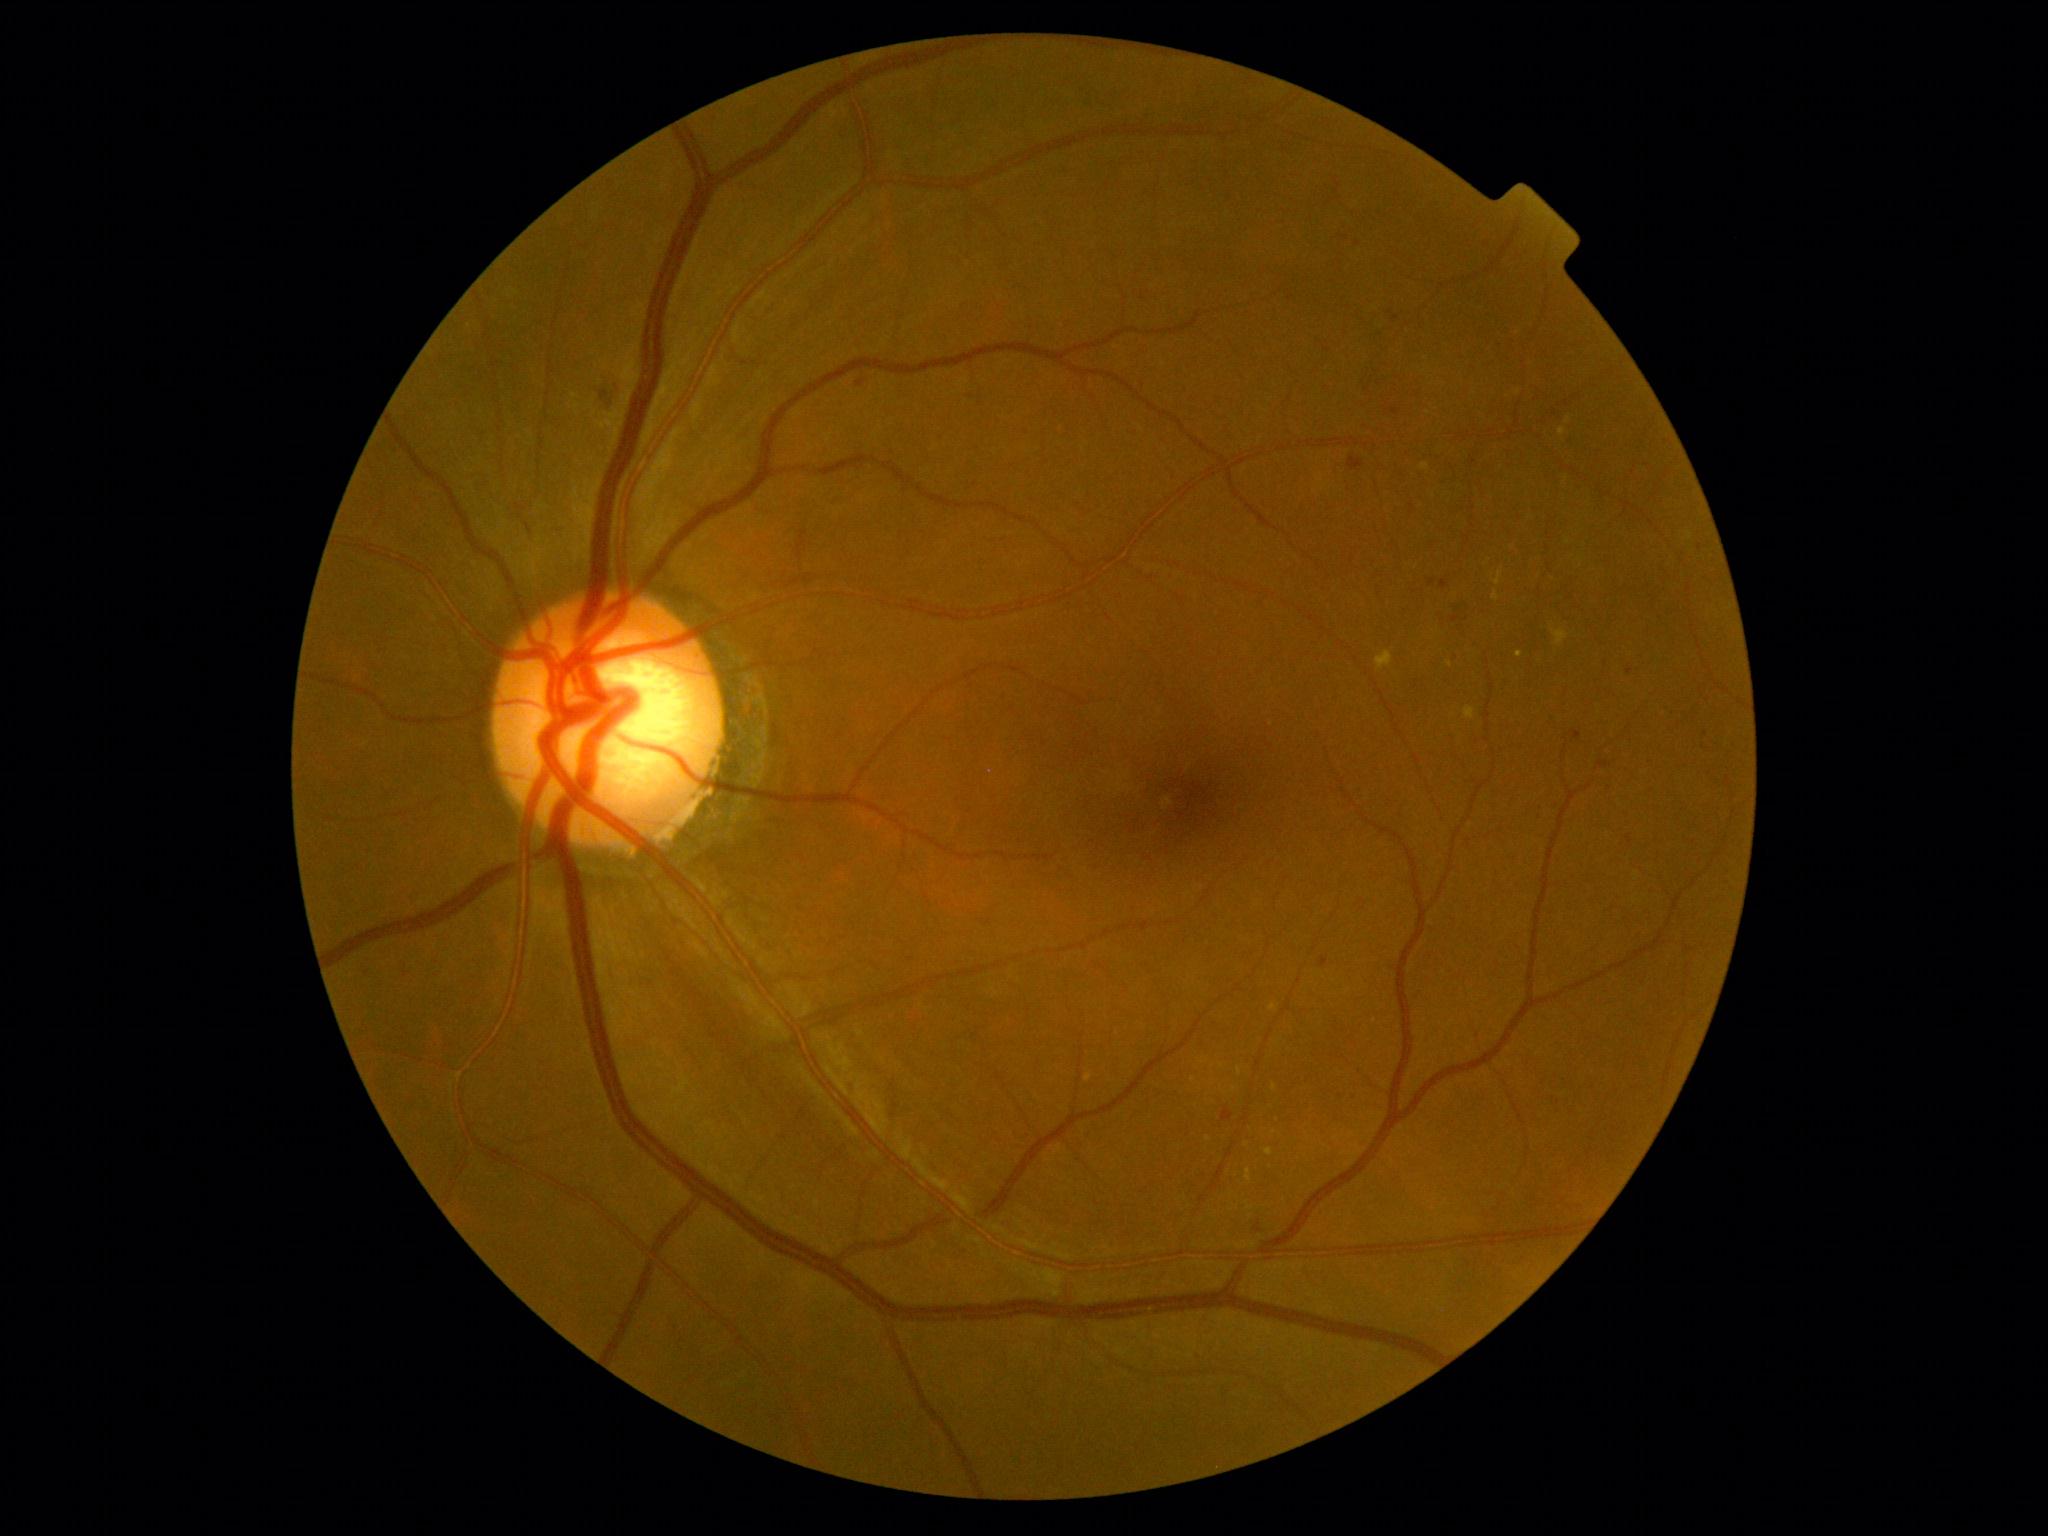
Diabetic retinopathy severity is grade 2 — more than just microaneurysms but less than severe NPDR.
The retinopathy is classified as non-proliferative diabetic retinopathy.